Image size 2352x1568 — 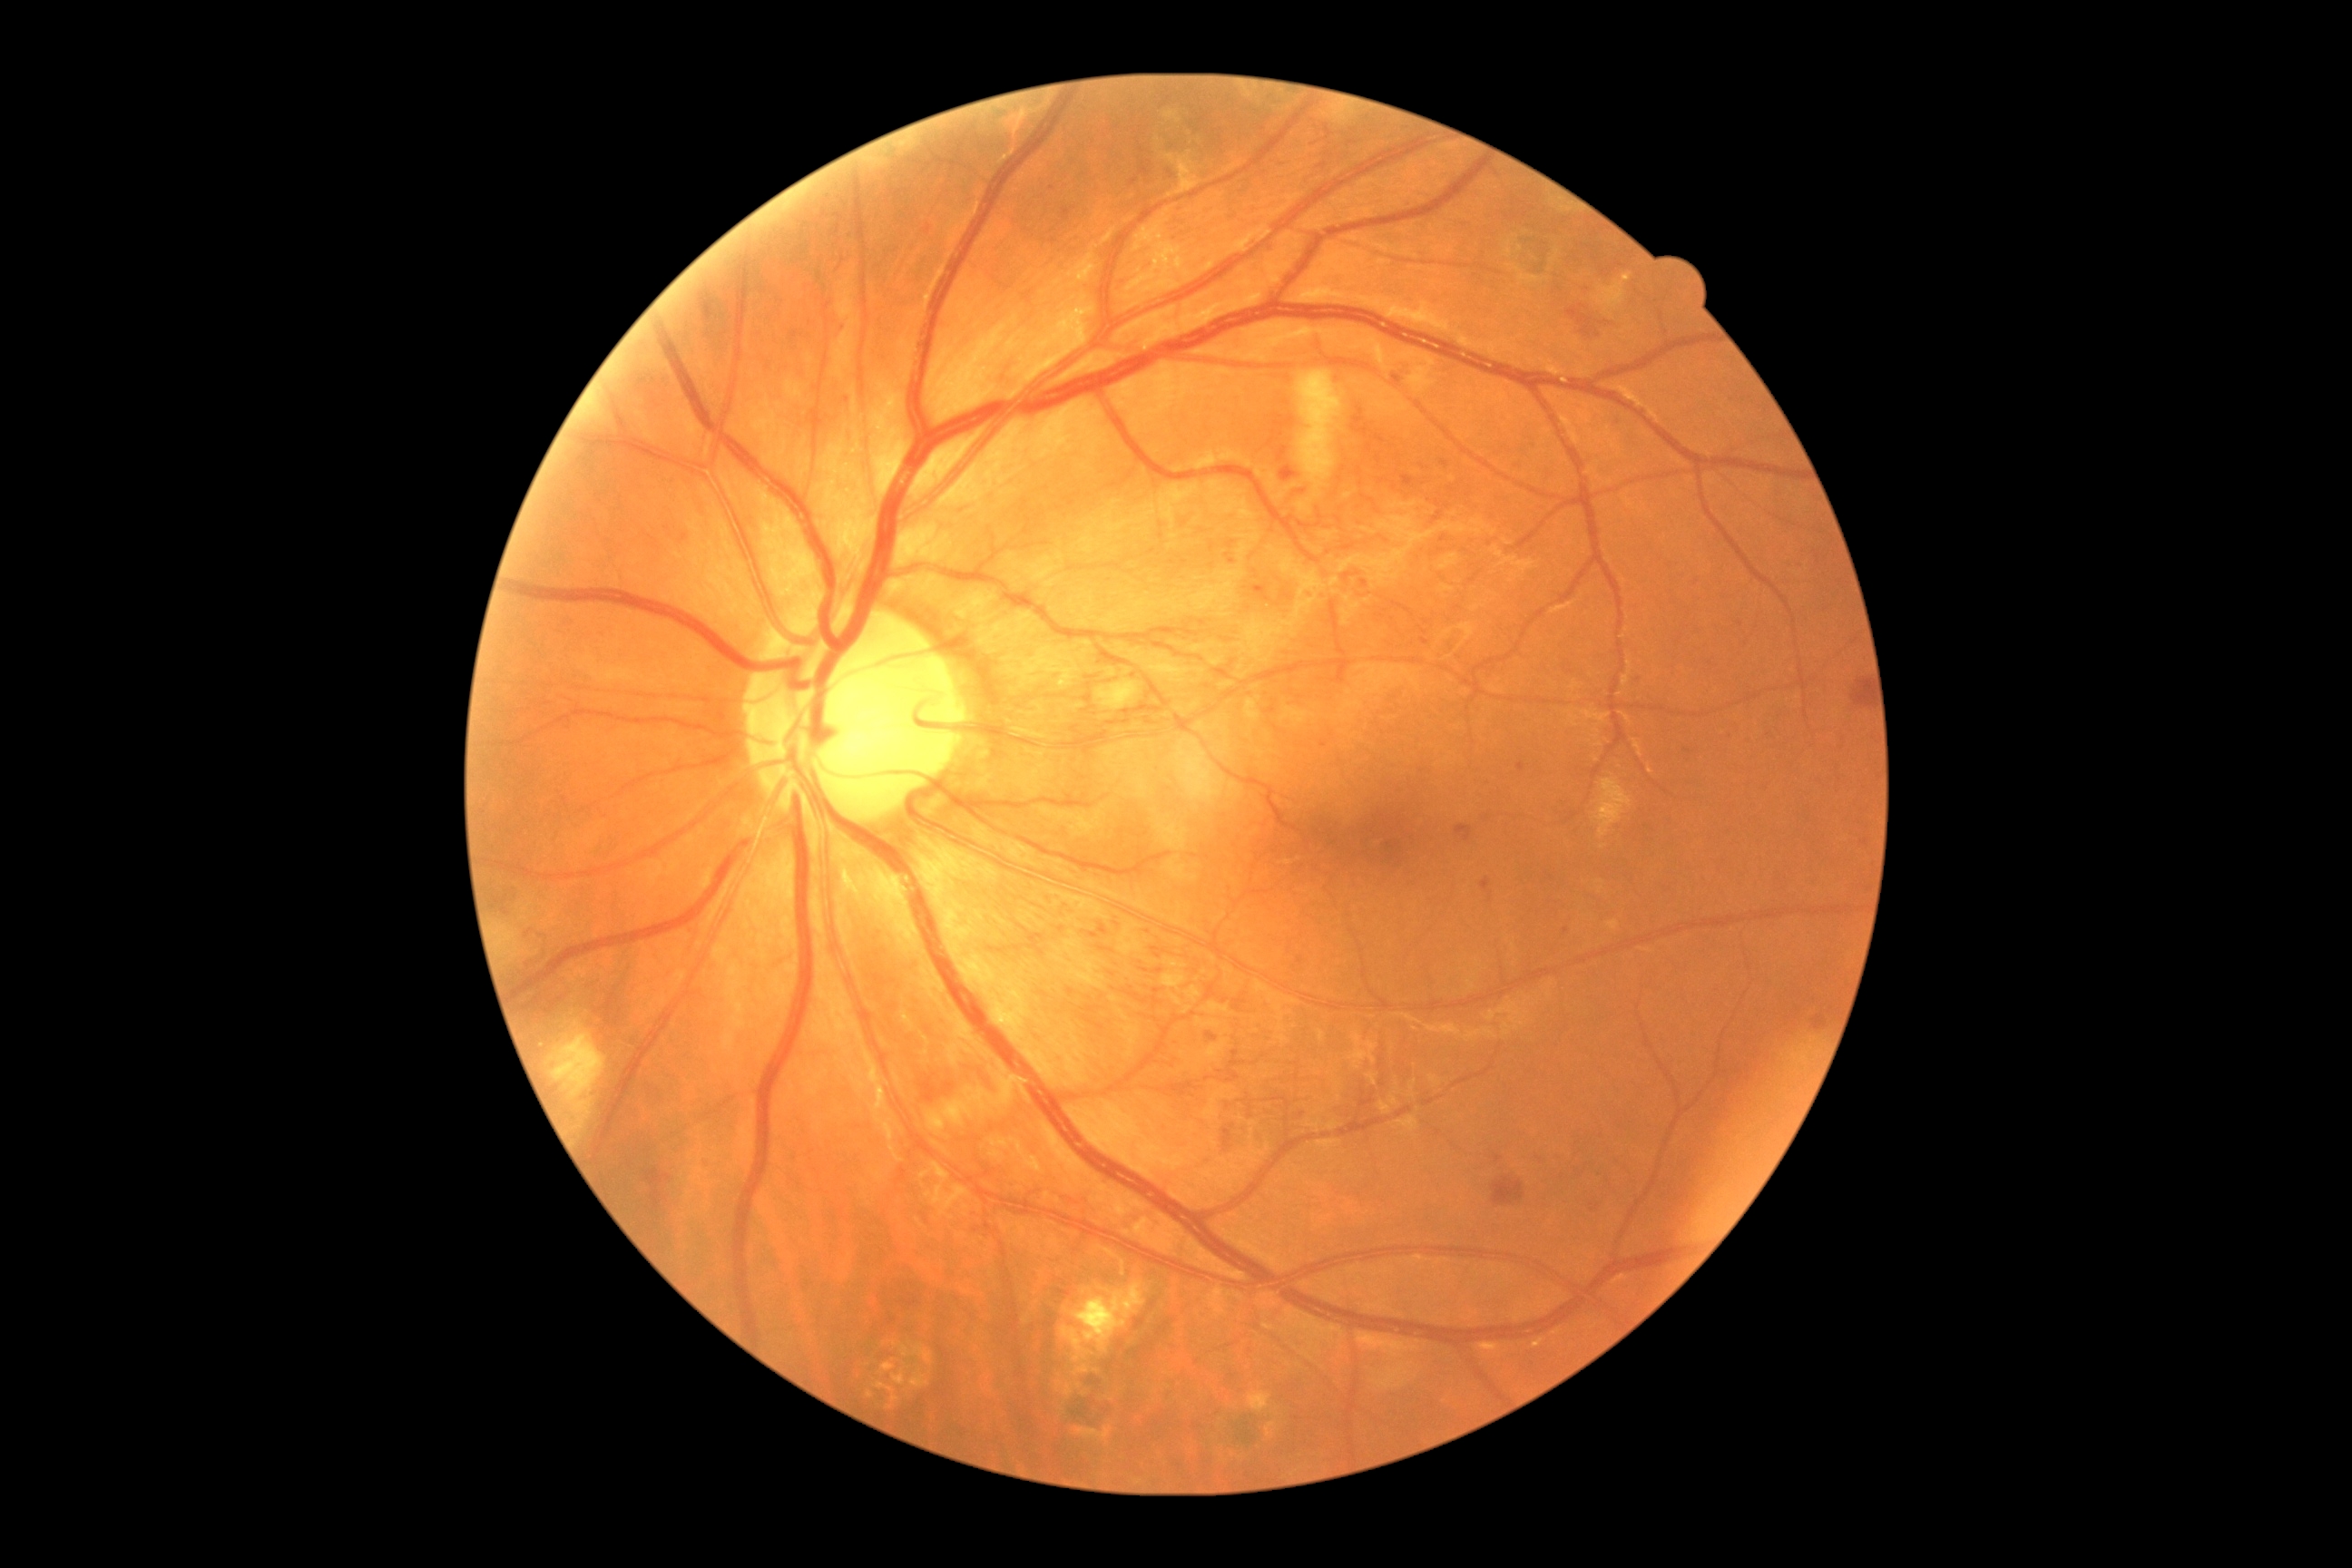 Annotations:
* DR class — non-proliferative diabetic retinopathy
* DR grade — severe NPDR (3)